Fundus photo: 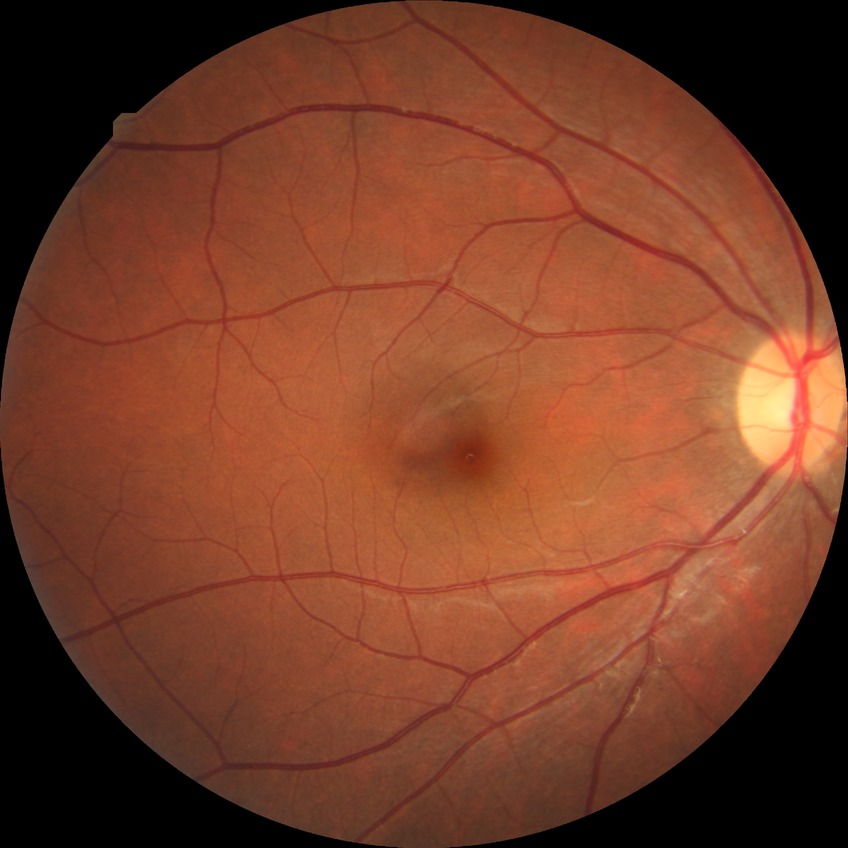

{
  "davis_grade": "no diabetic retinopathy (NDR)"
}